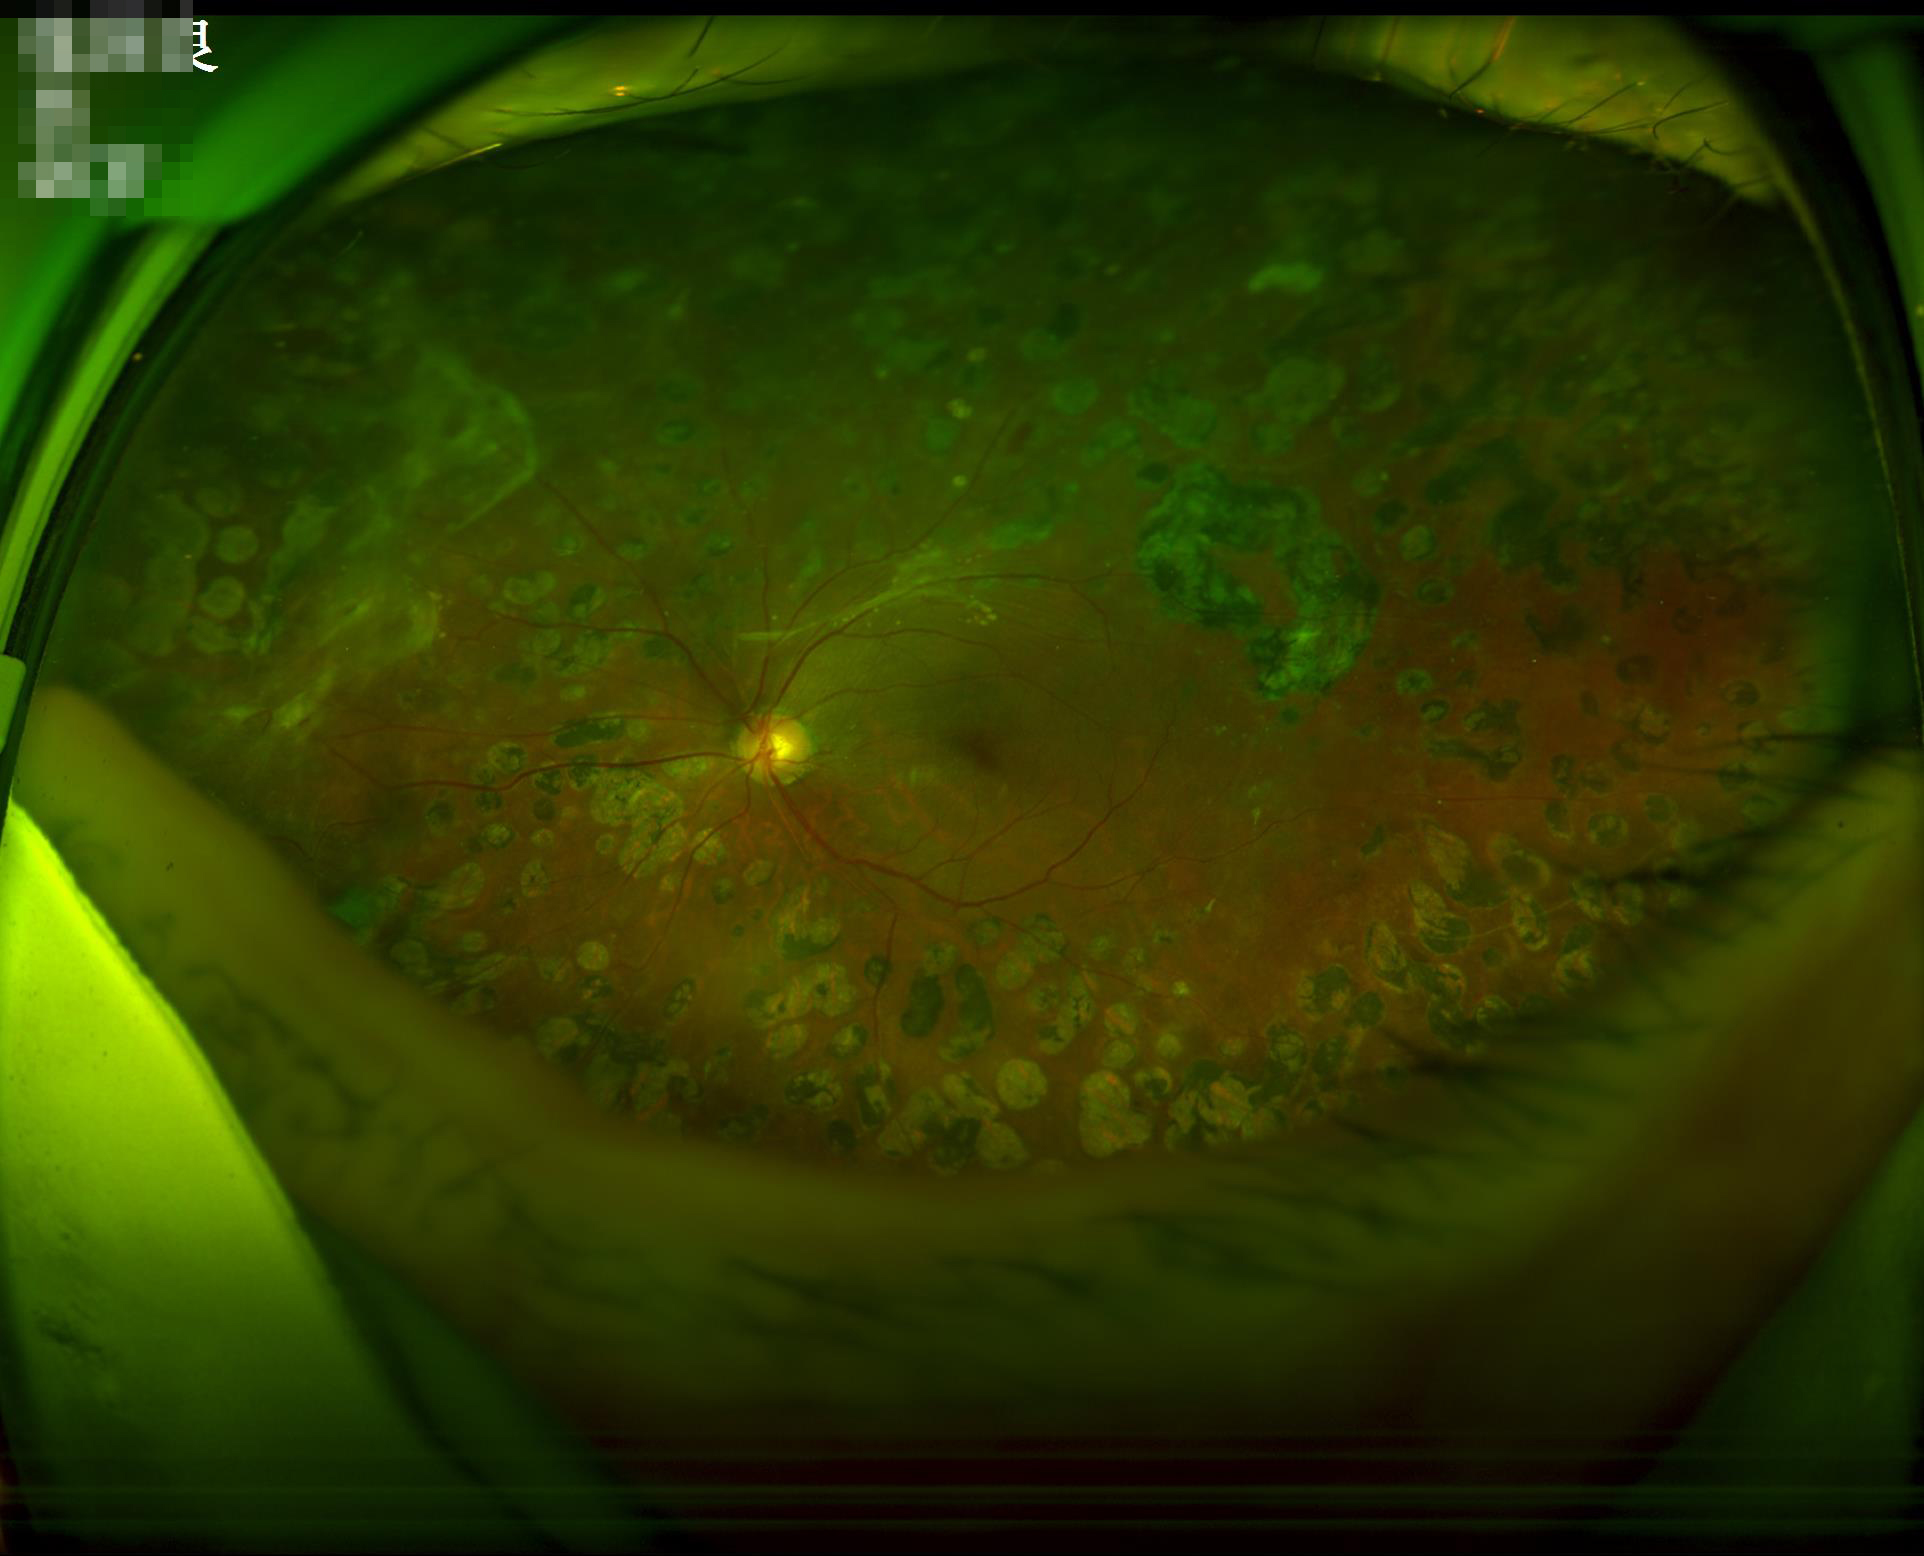
No over- or under-exposure. No noticeable blur. Good dynamic range. Overall image quality is good.